Davis DR grading: 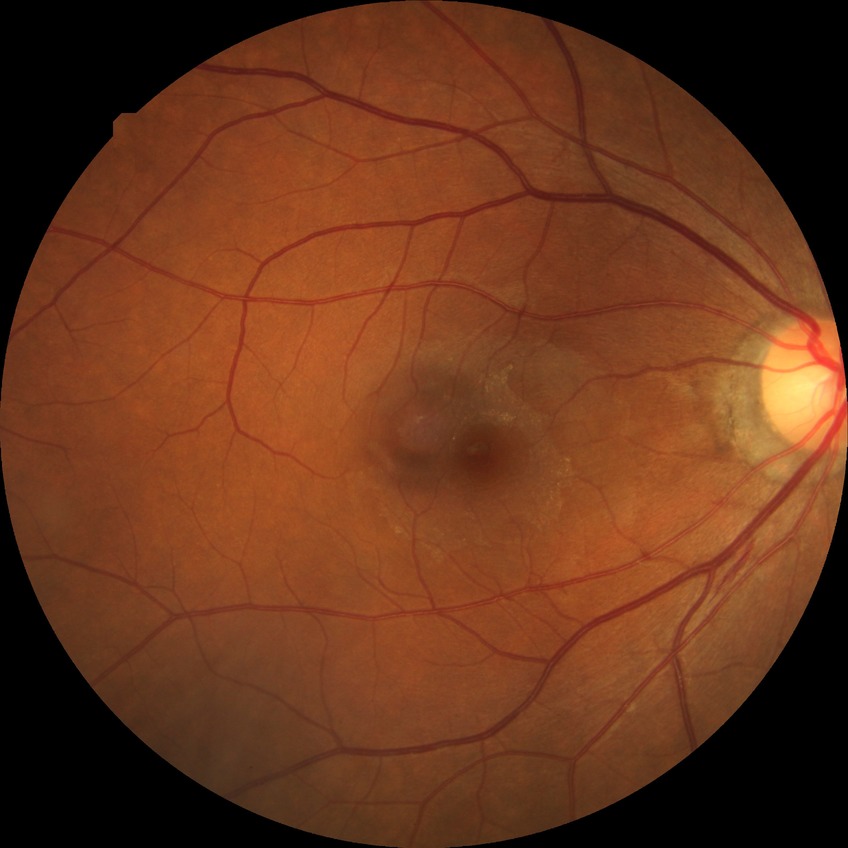

Diabetic retinopathy stage is no diabetic retinopathy.